Modified Davis classification: 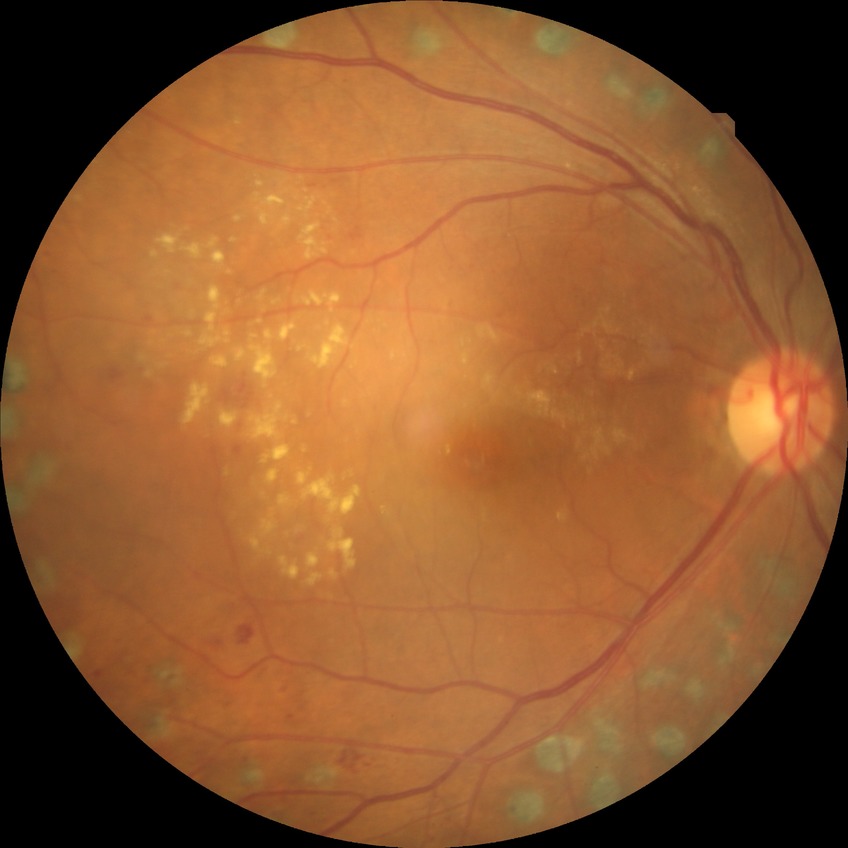
Modified Davis classification: proliferative diabetic retinopathy.